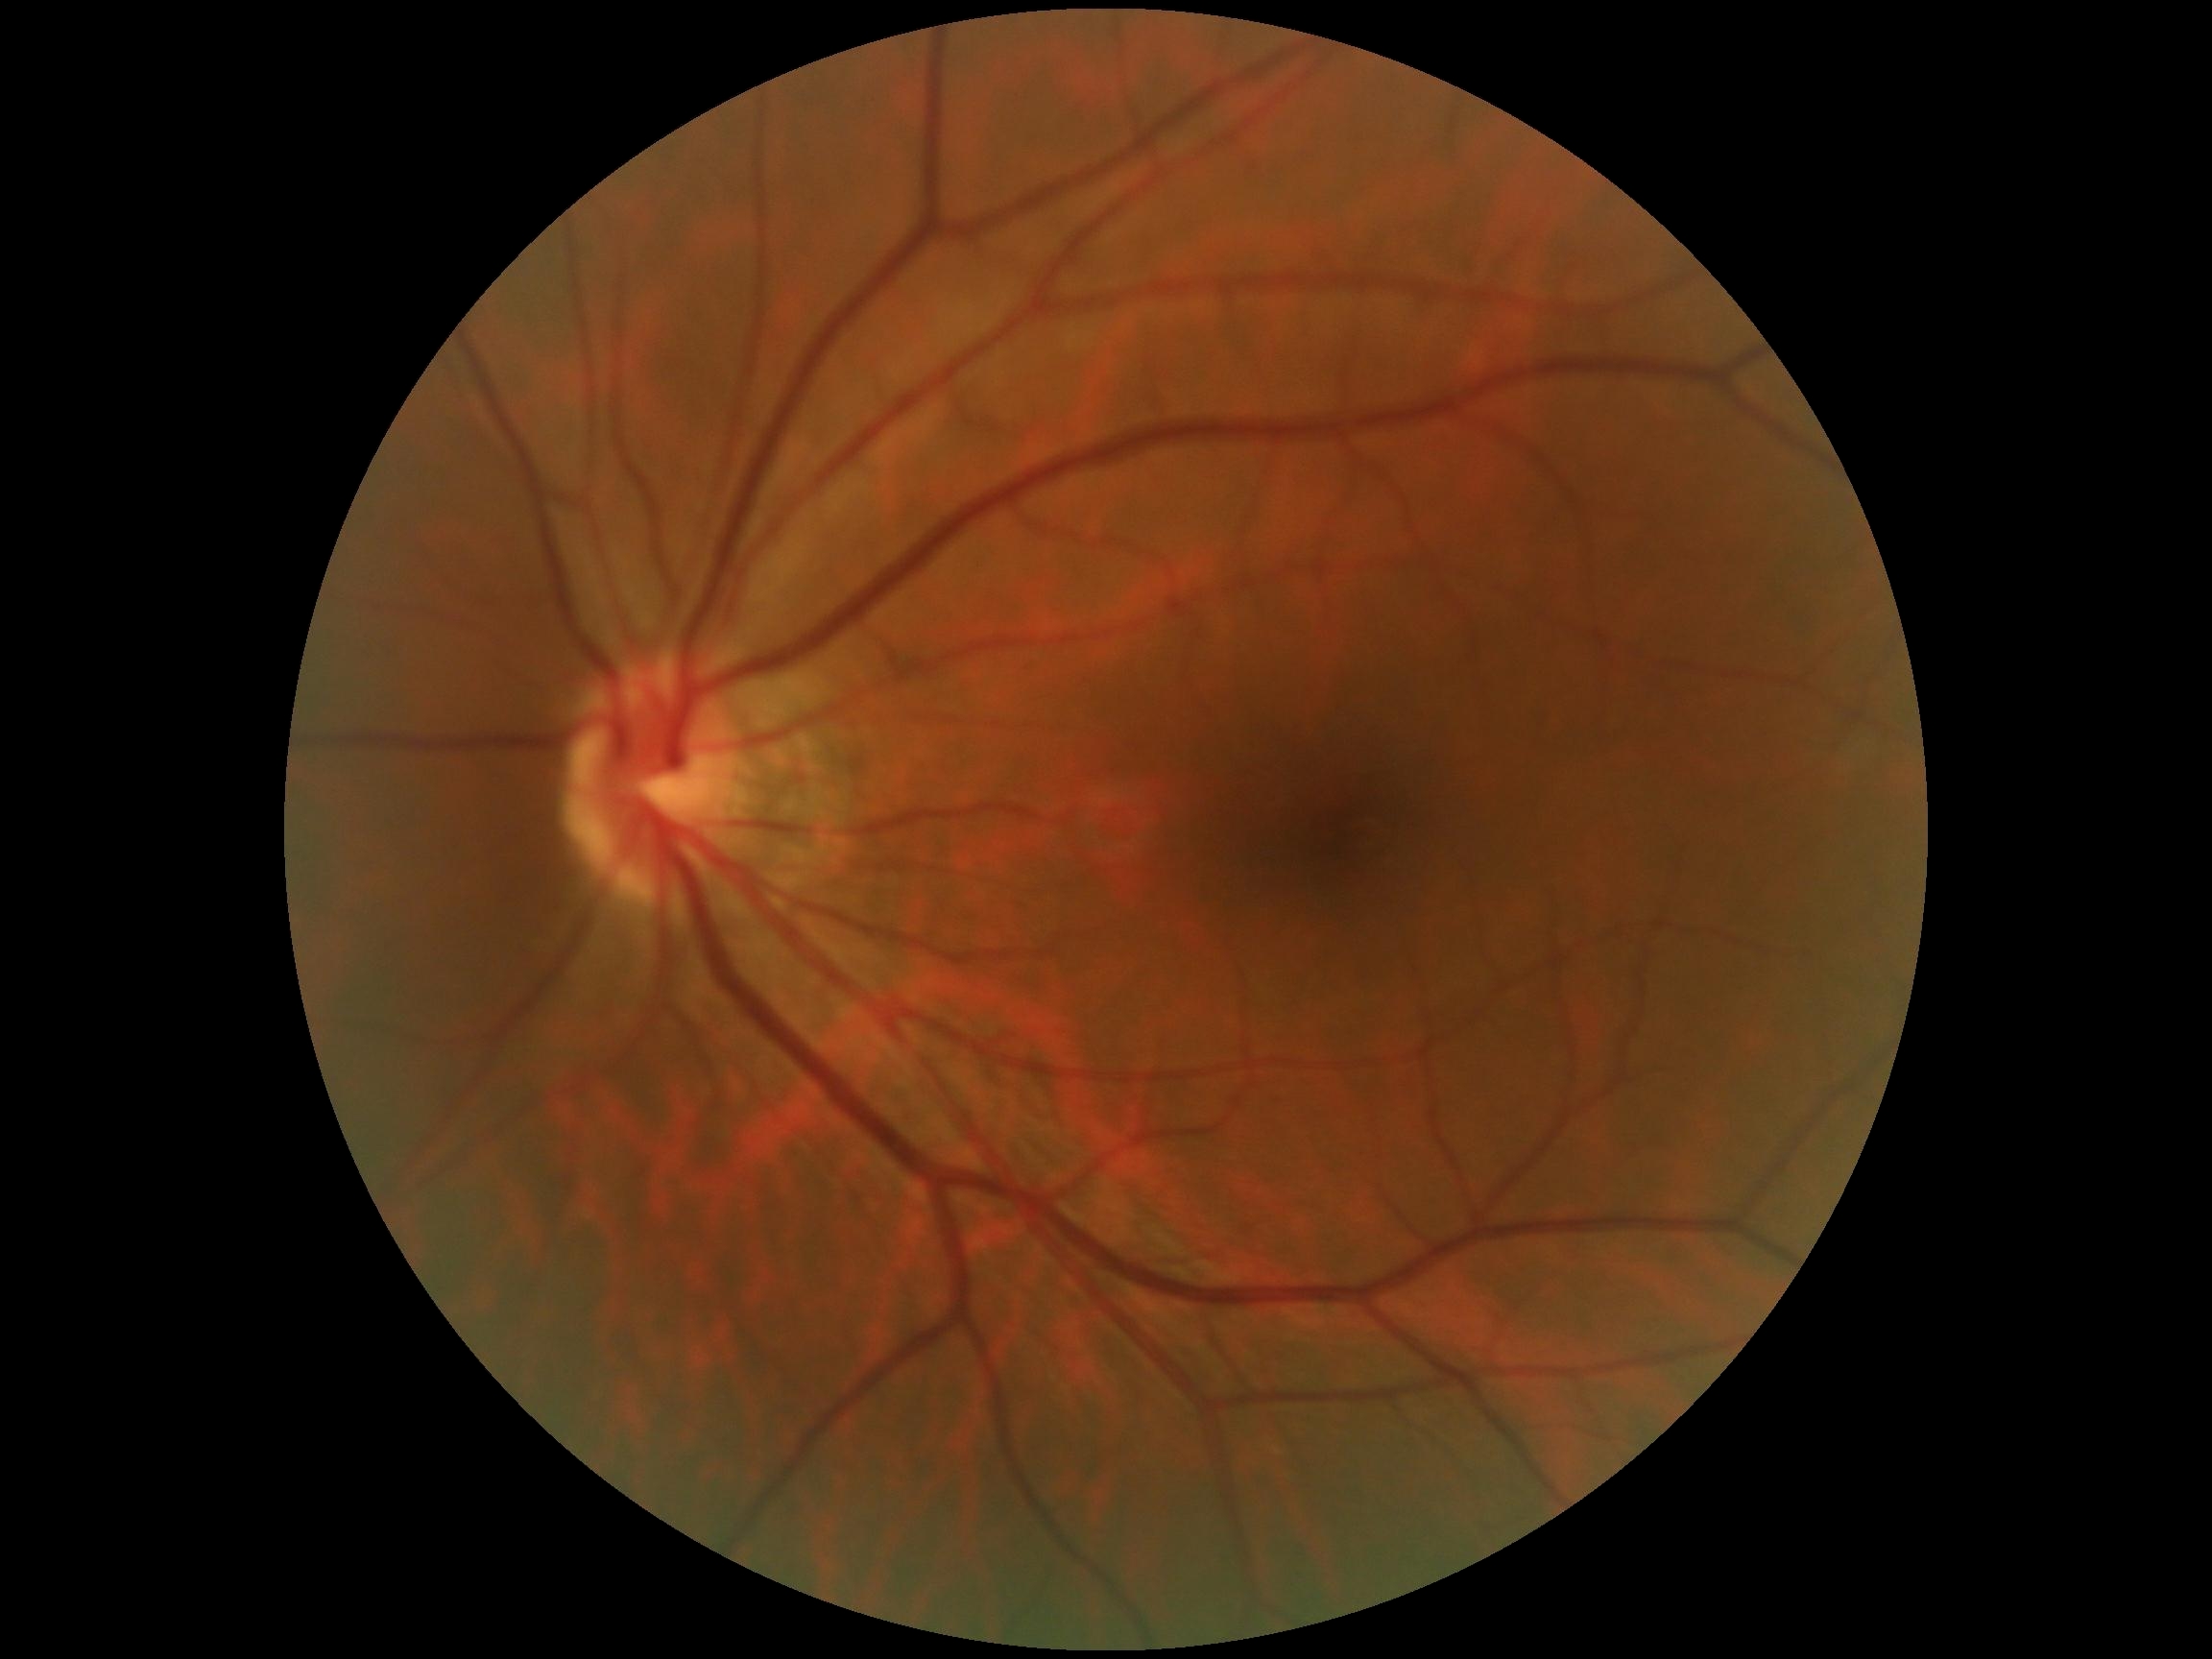

dr_impression: no DR findings
dr_grade: no apparent retinopathy (grade 0)